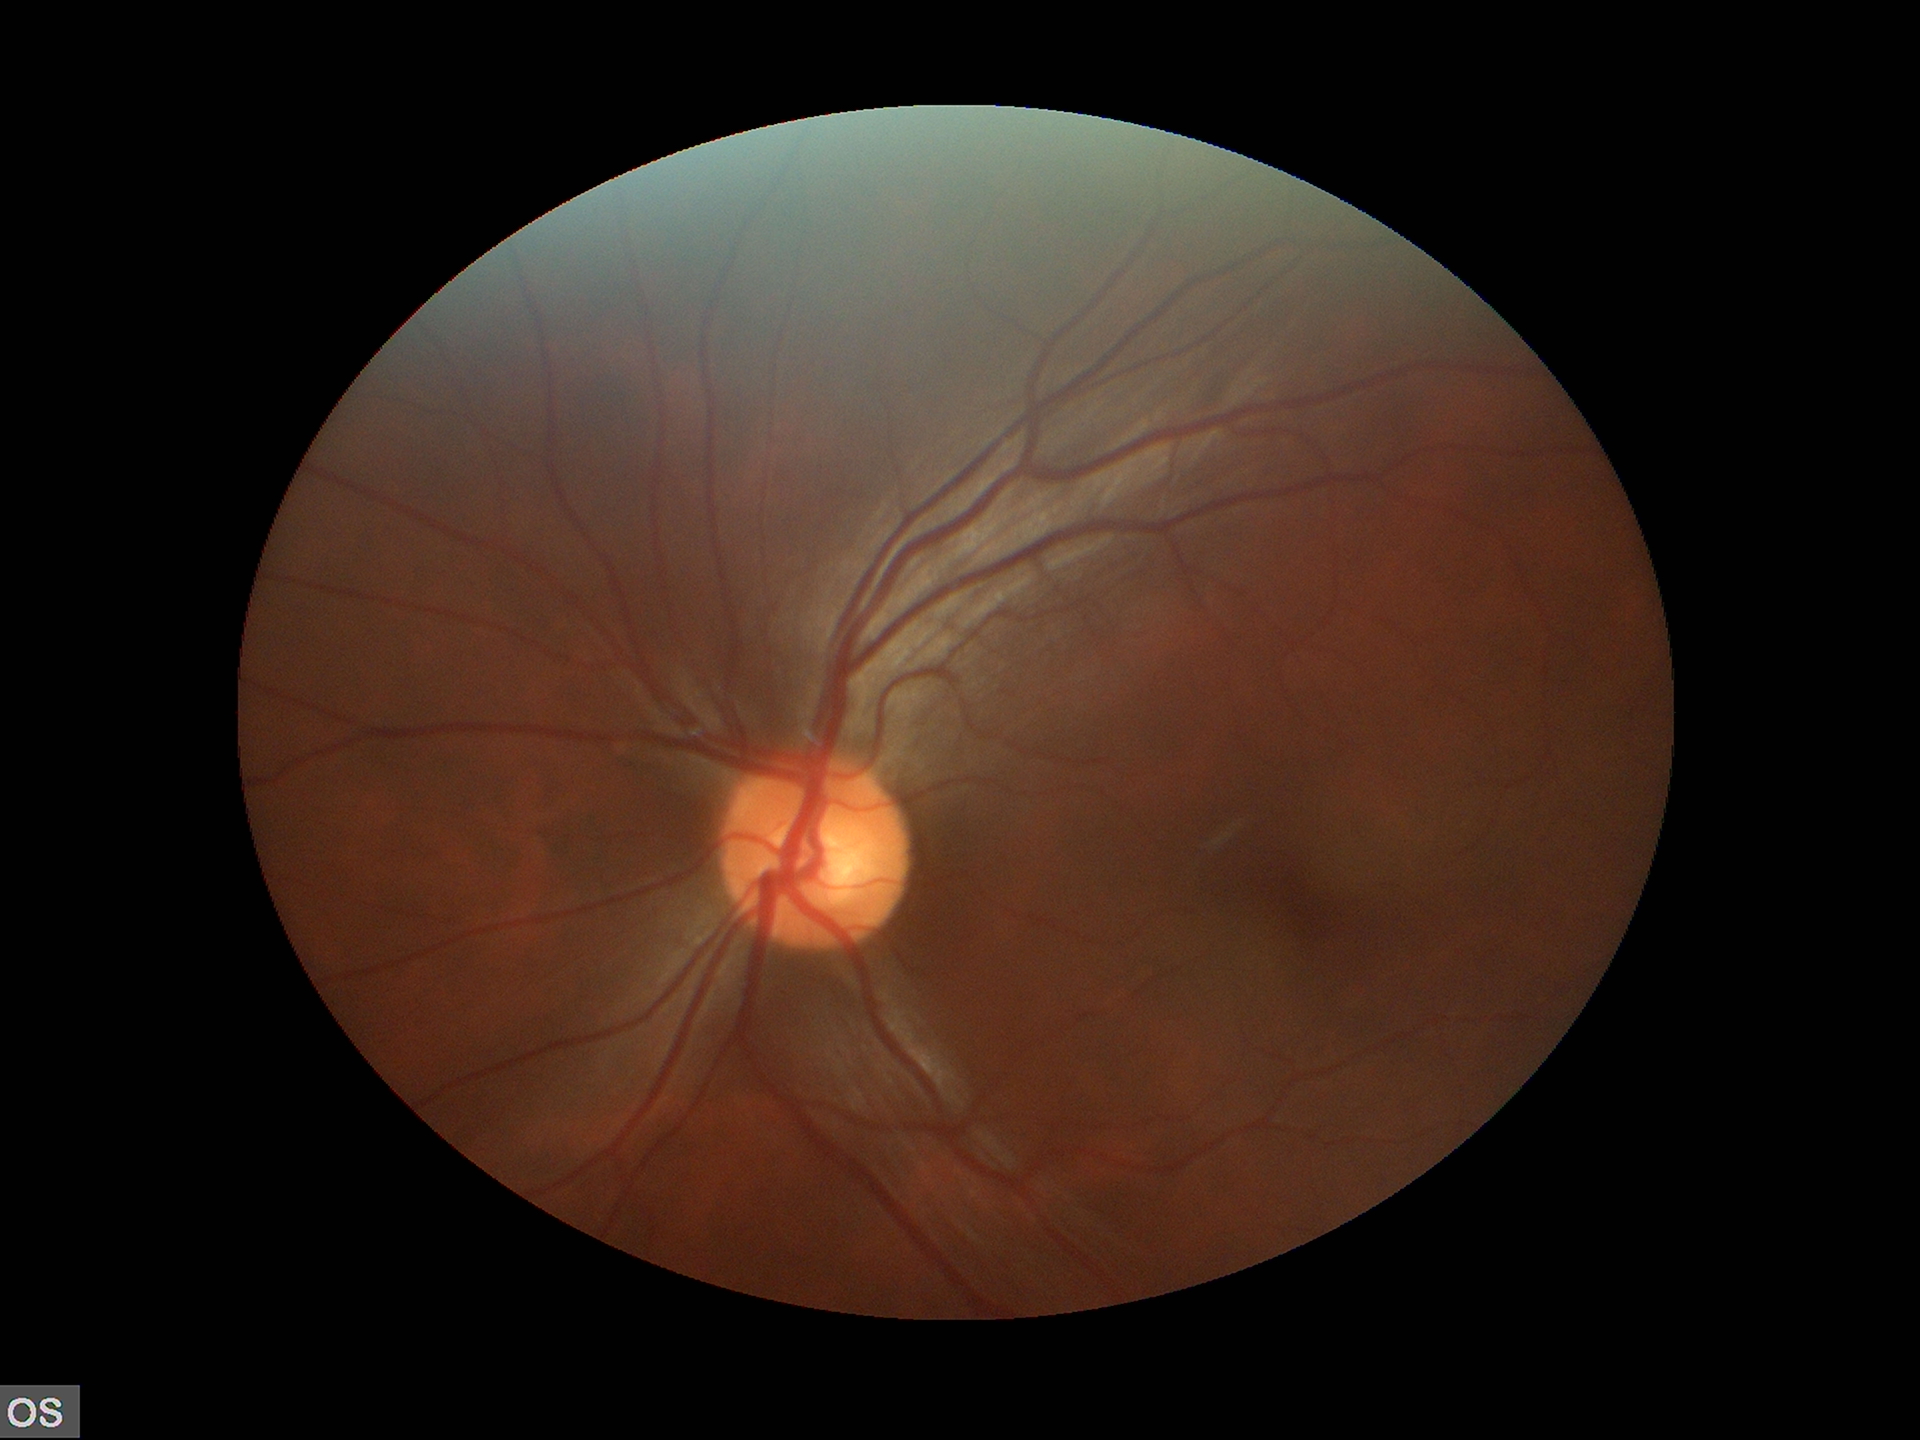 Glaucoma screening impression: no suspicious findings. Vertical cup-disc ratio is 0.55.